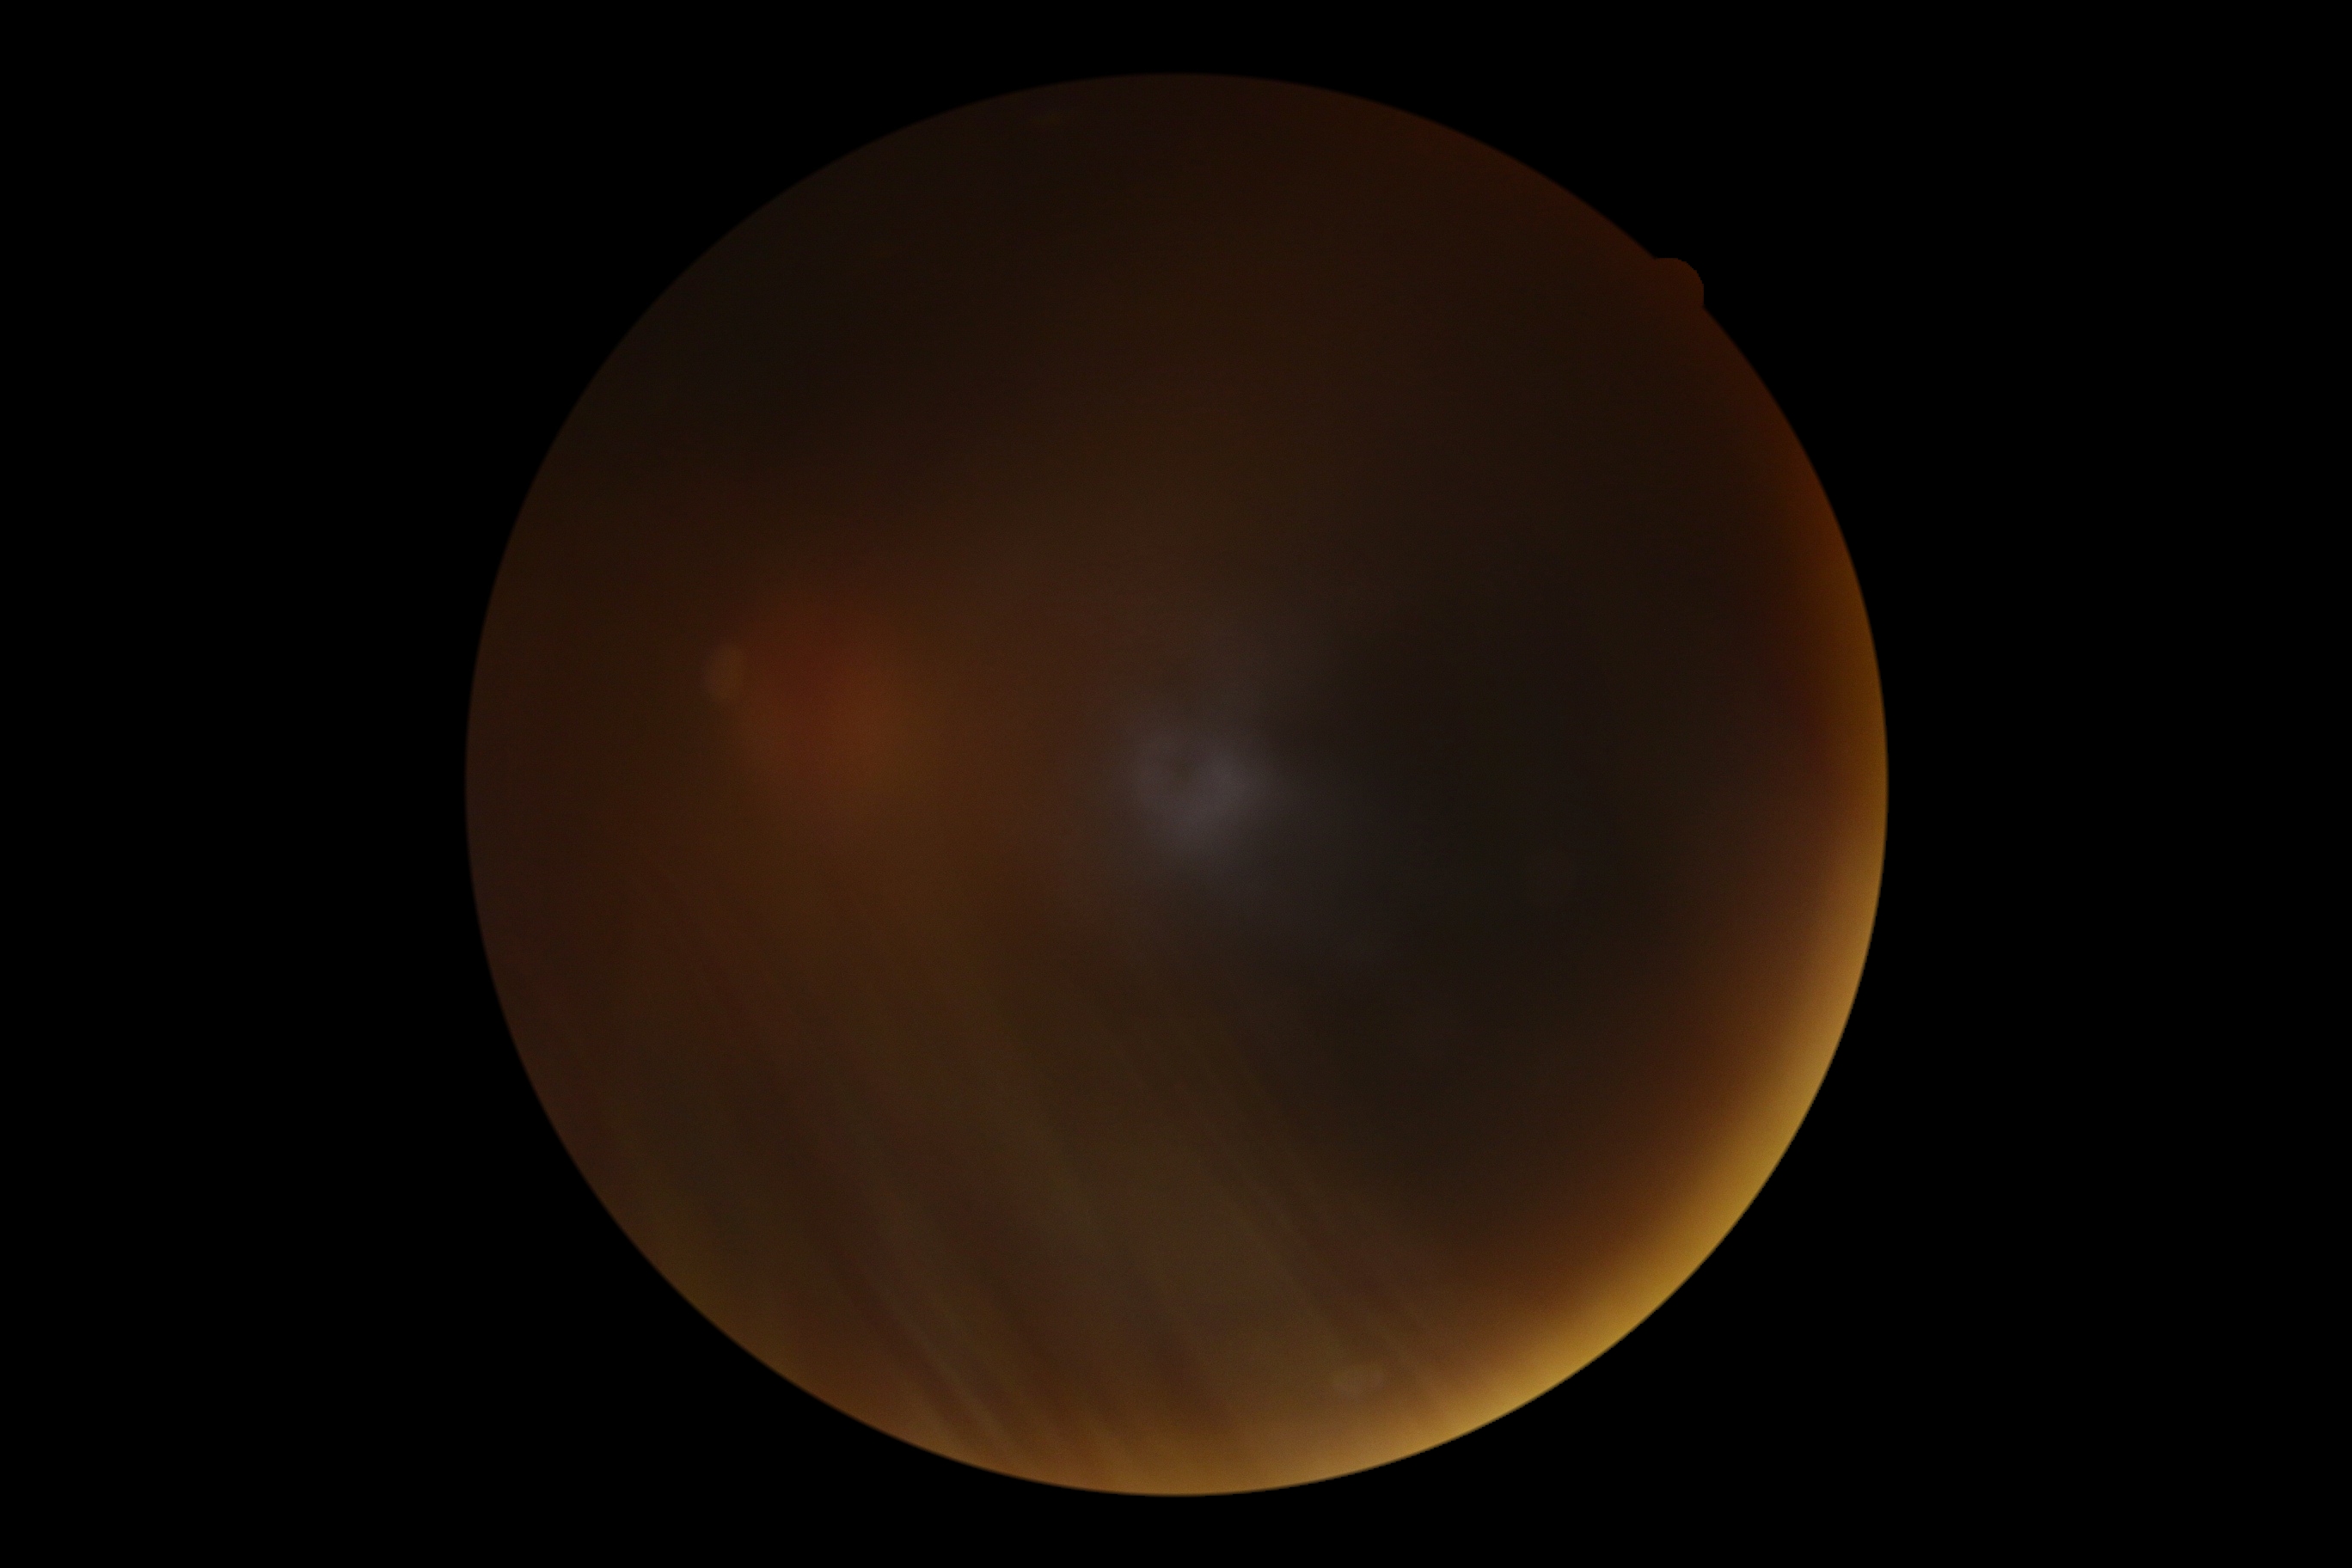

Findings:
* retinopathy — ungradable due to poor image quality
* image quality — insufficient for DR assessment